Camera: NIDEK AFC-230. Without pupil dilation. Davis DR grading — 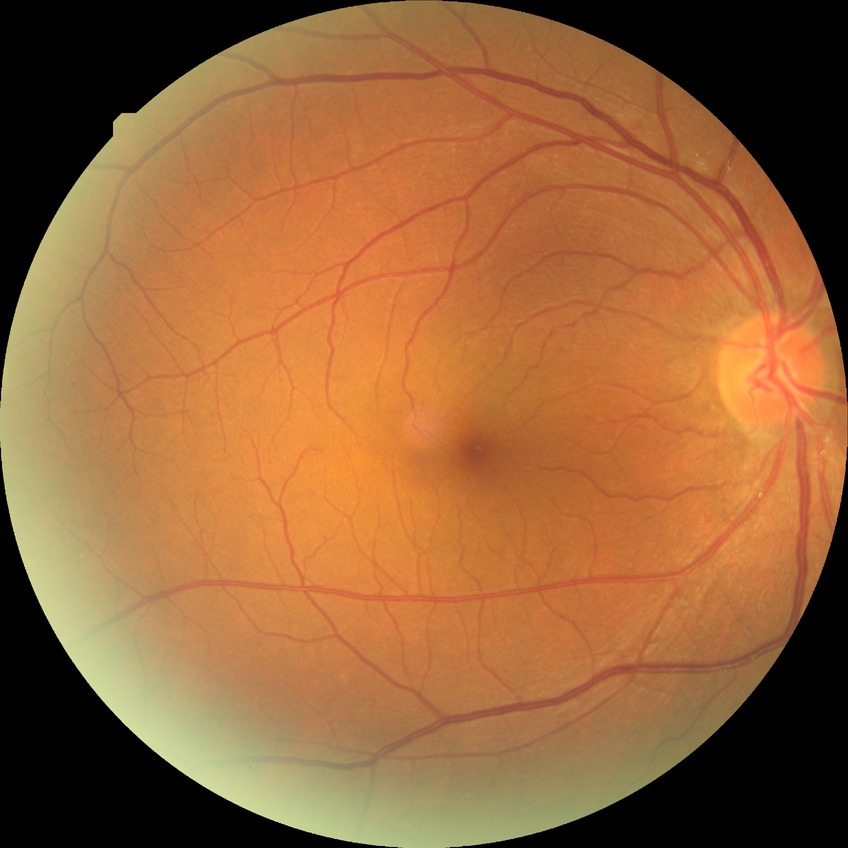 modified Davis grading=no diabetic retinopathy.